Fundus photo · 45-degree field of view · 2212 by 1659 pixels.
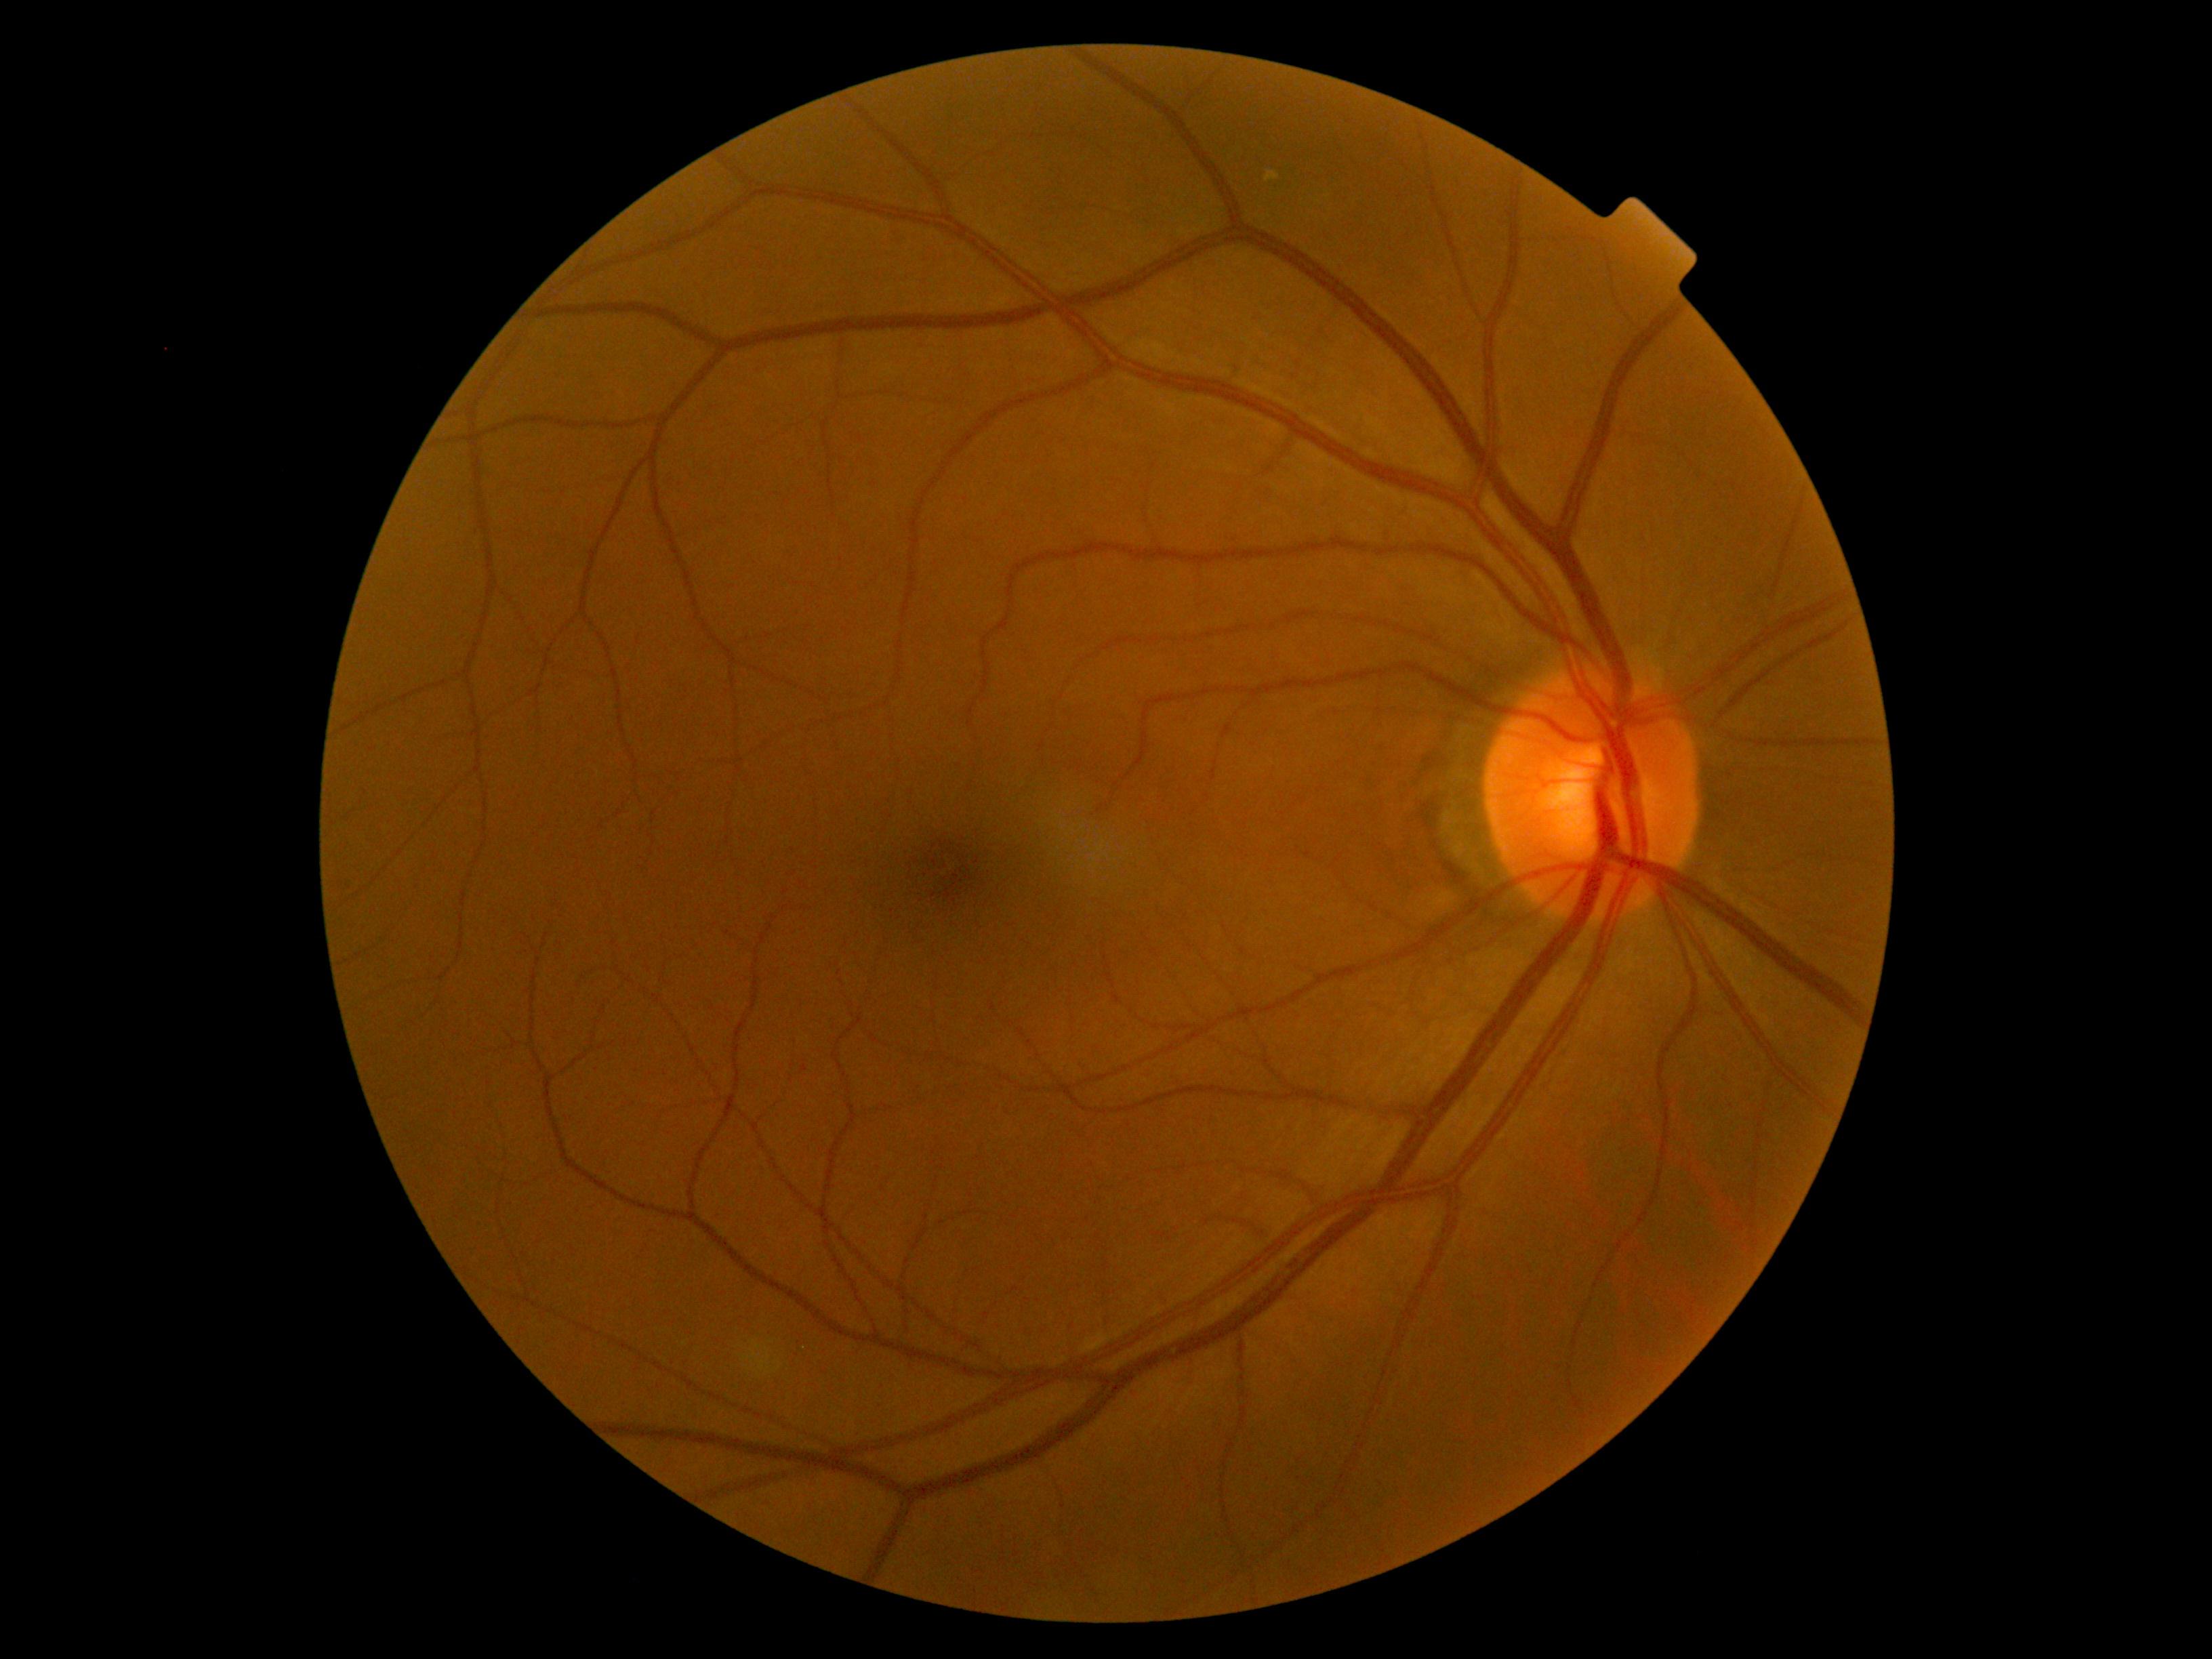
DR is 0. No DR findings.